Diabetic retinopathy graded by the modified Davis classification.
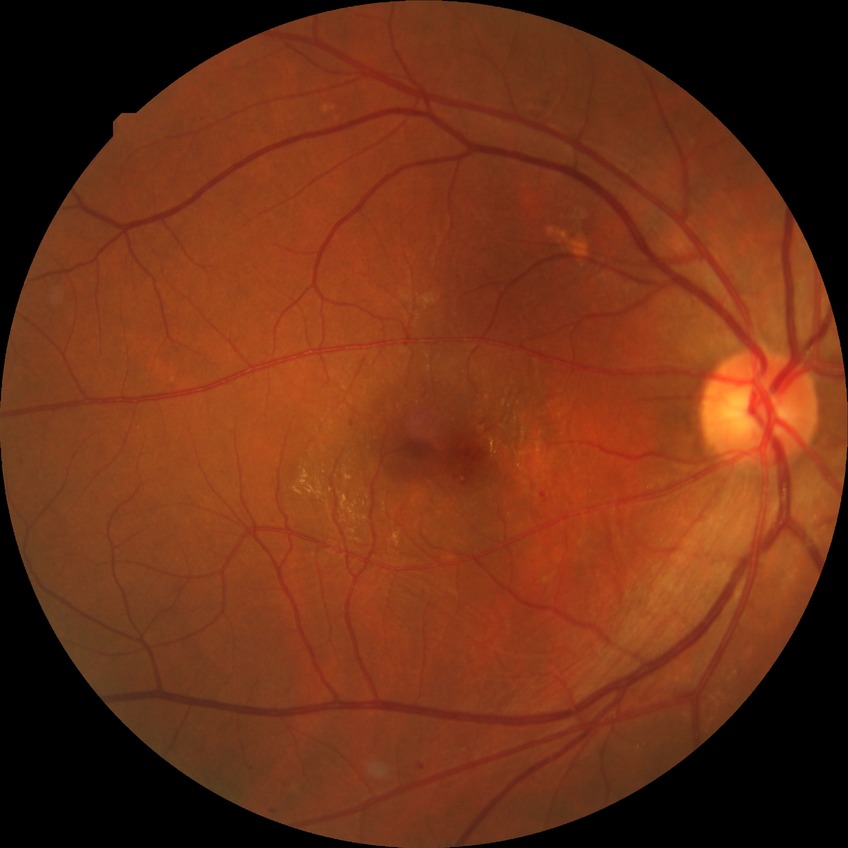 diabetic retinopathy (DR)@simple diabetic retinopathy (SDR).